No pharmacologic dilation; FOV: 45 degrees
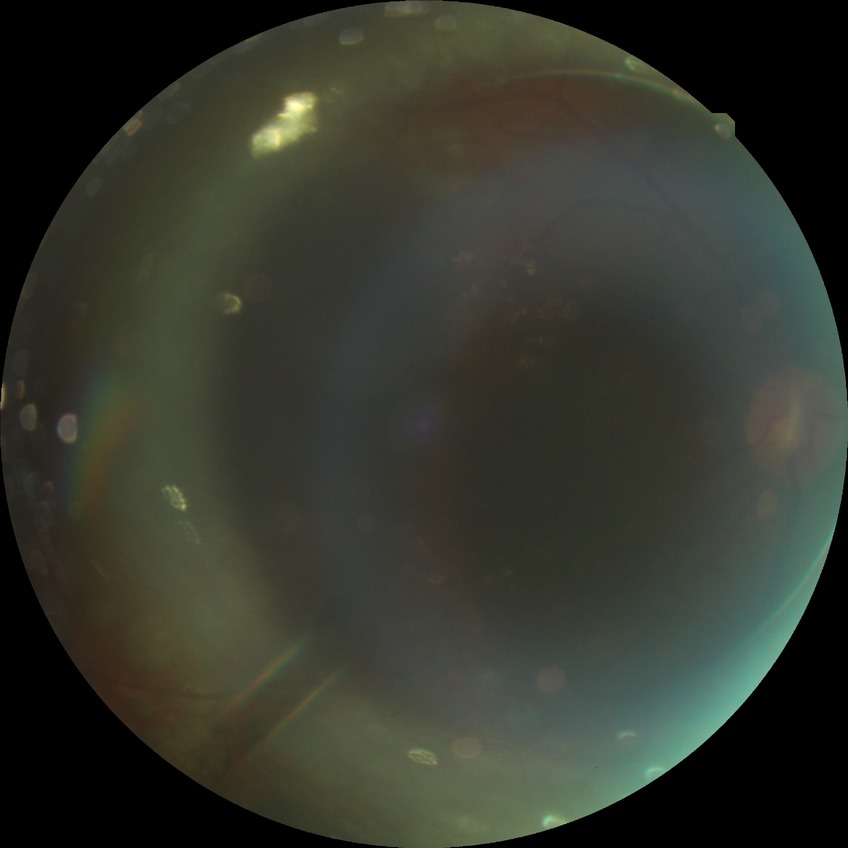

diabetic retinopathy (DR)=PDR (proliferative diabetic retinopathy).